1240 by 1240 pixels · Phoenix ICON wide-field infant fundus image
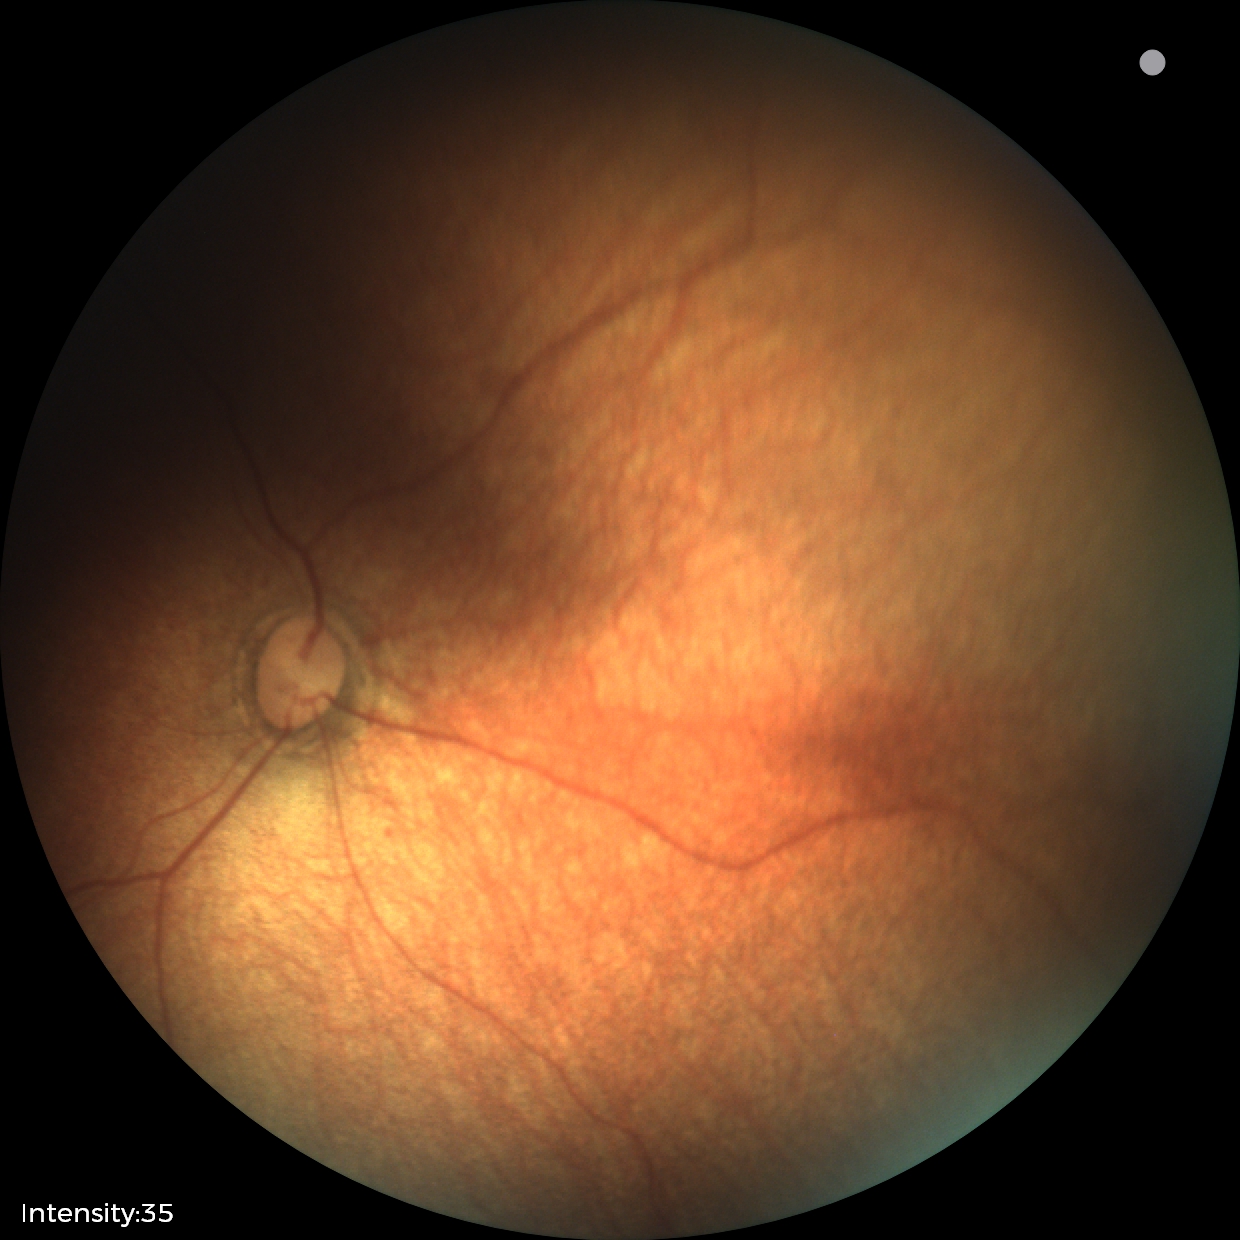
Screening diagnosis: physiological finding.